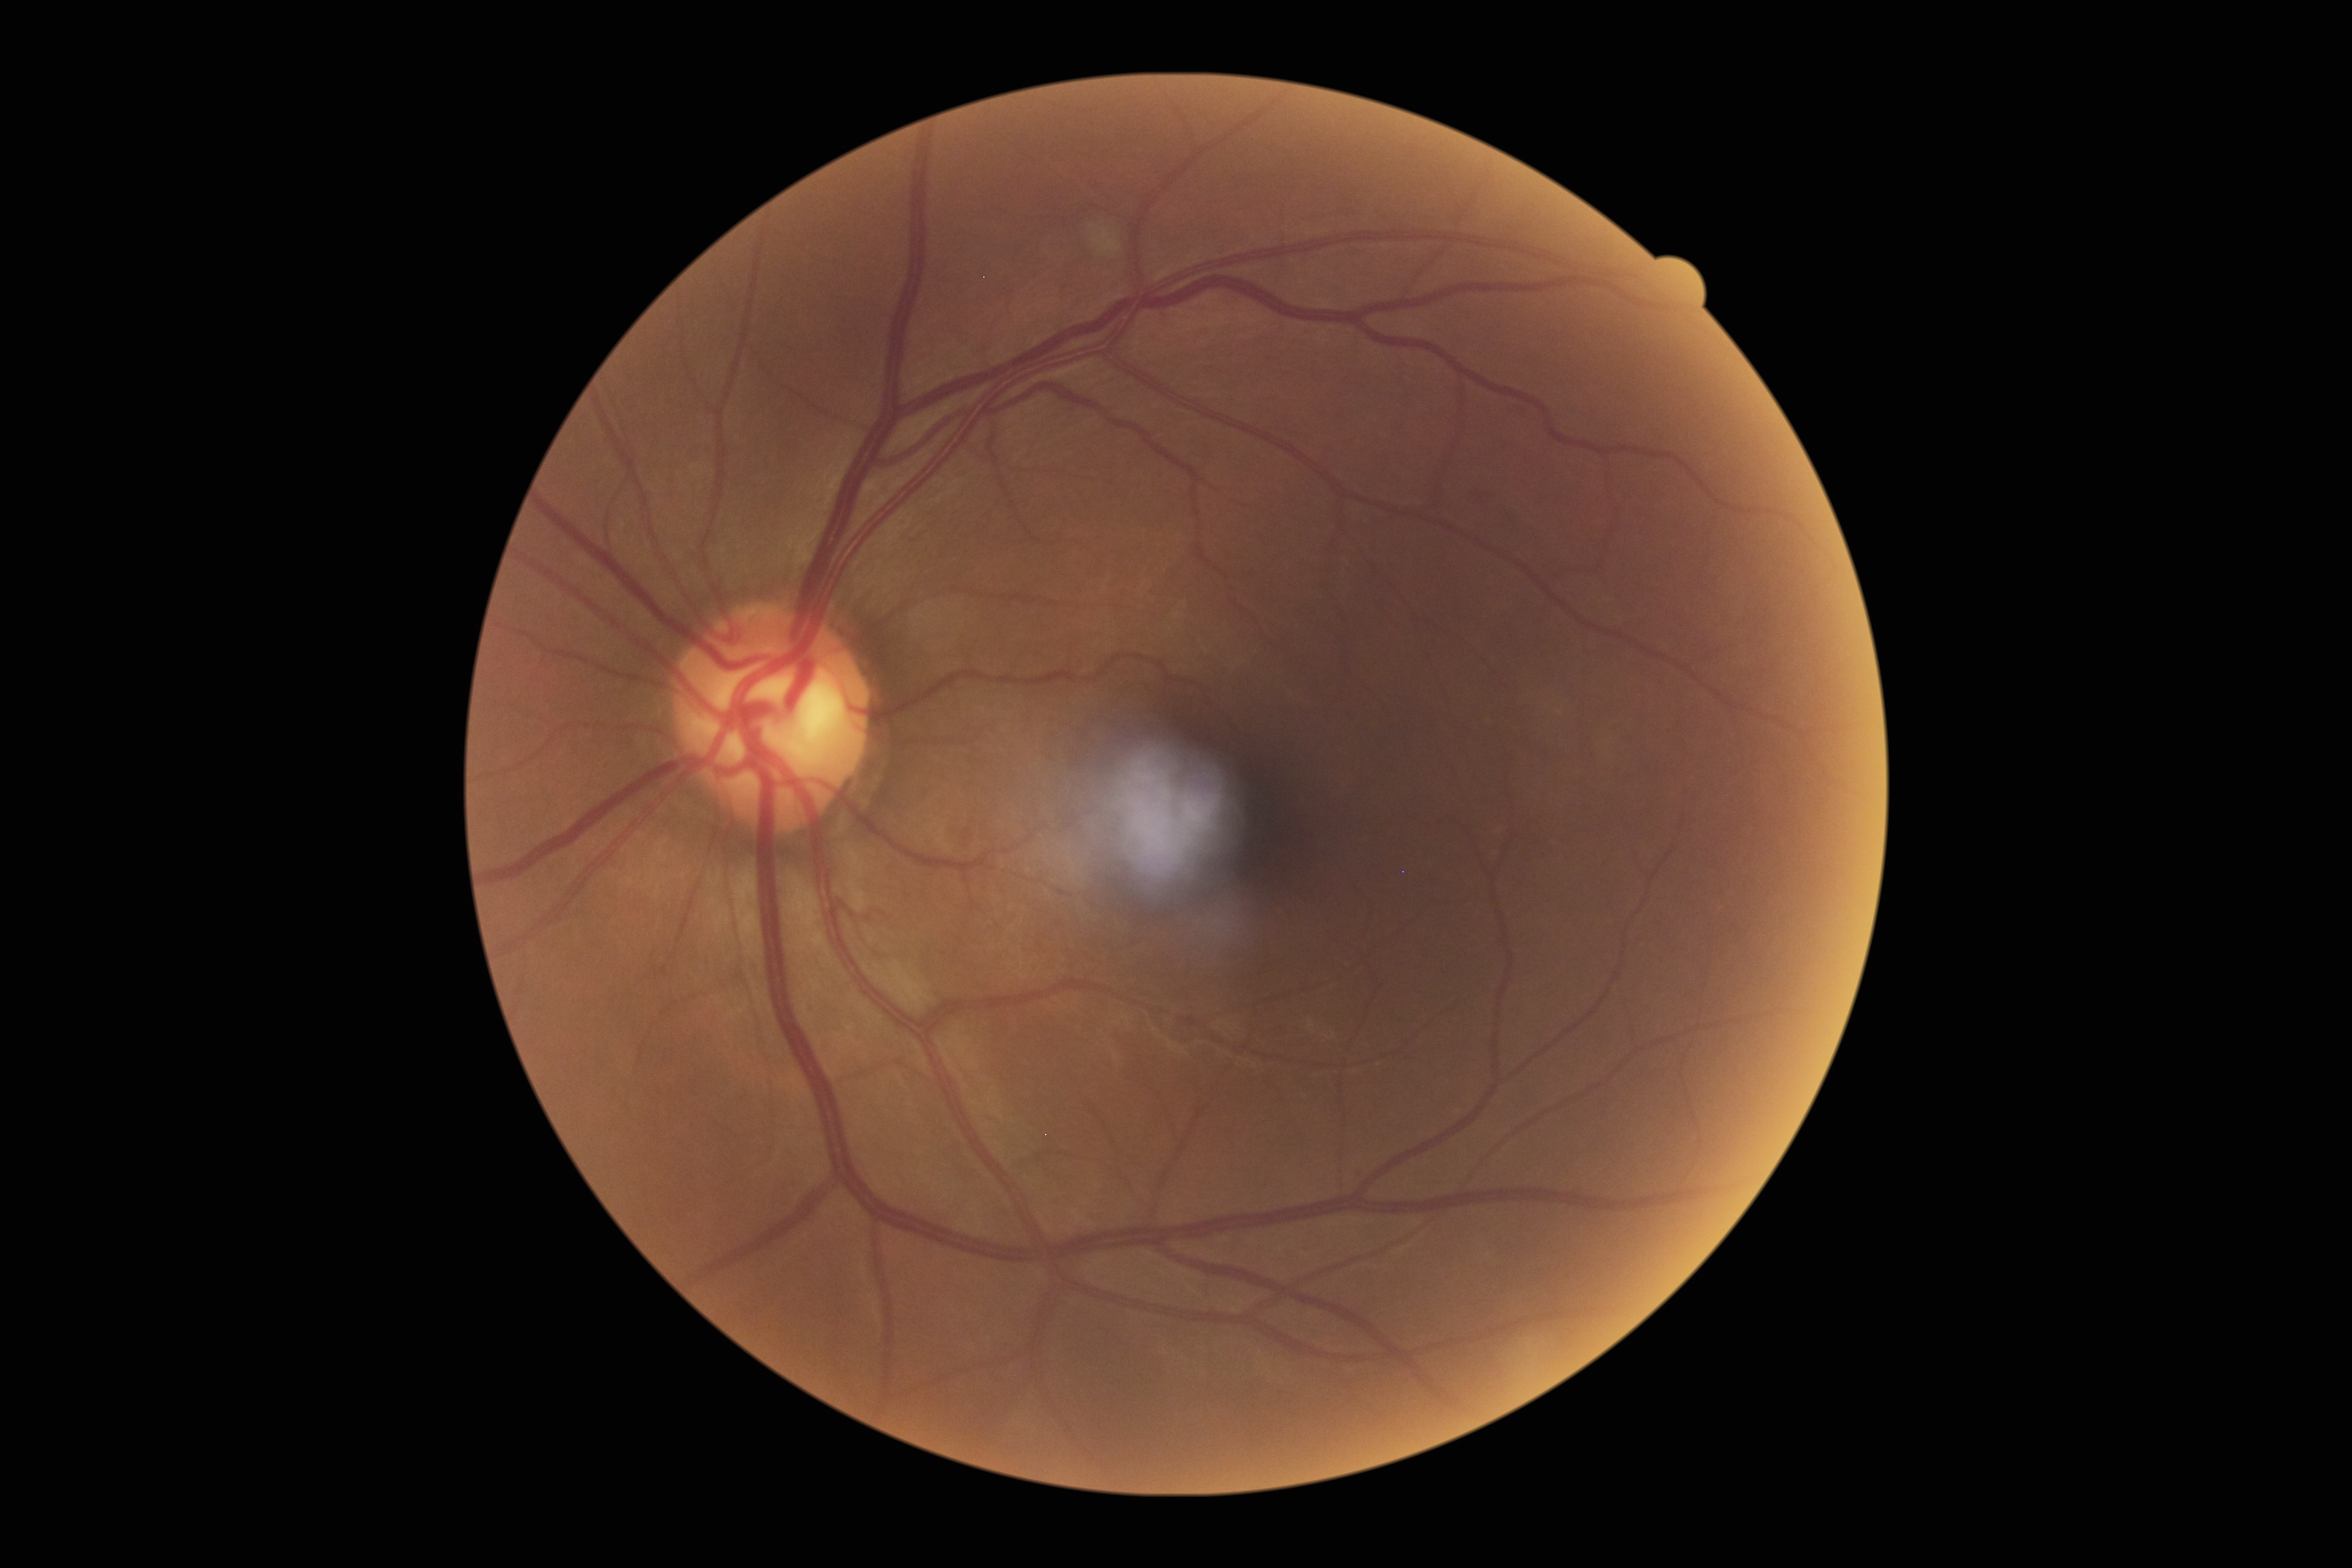
DR is 2.